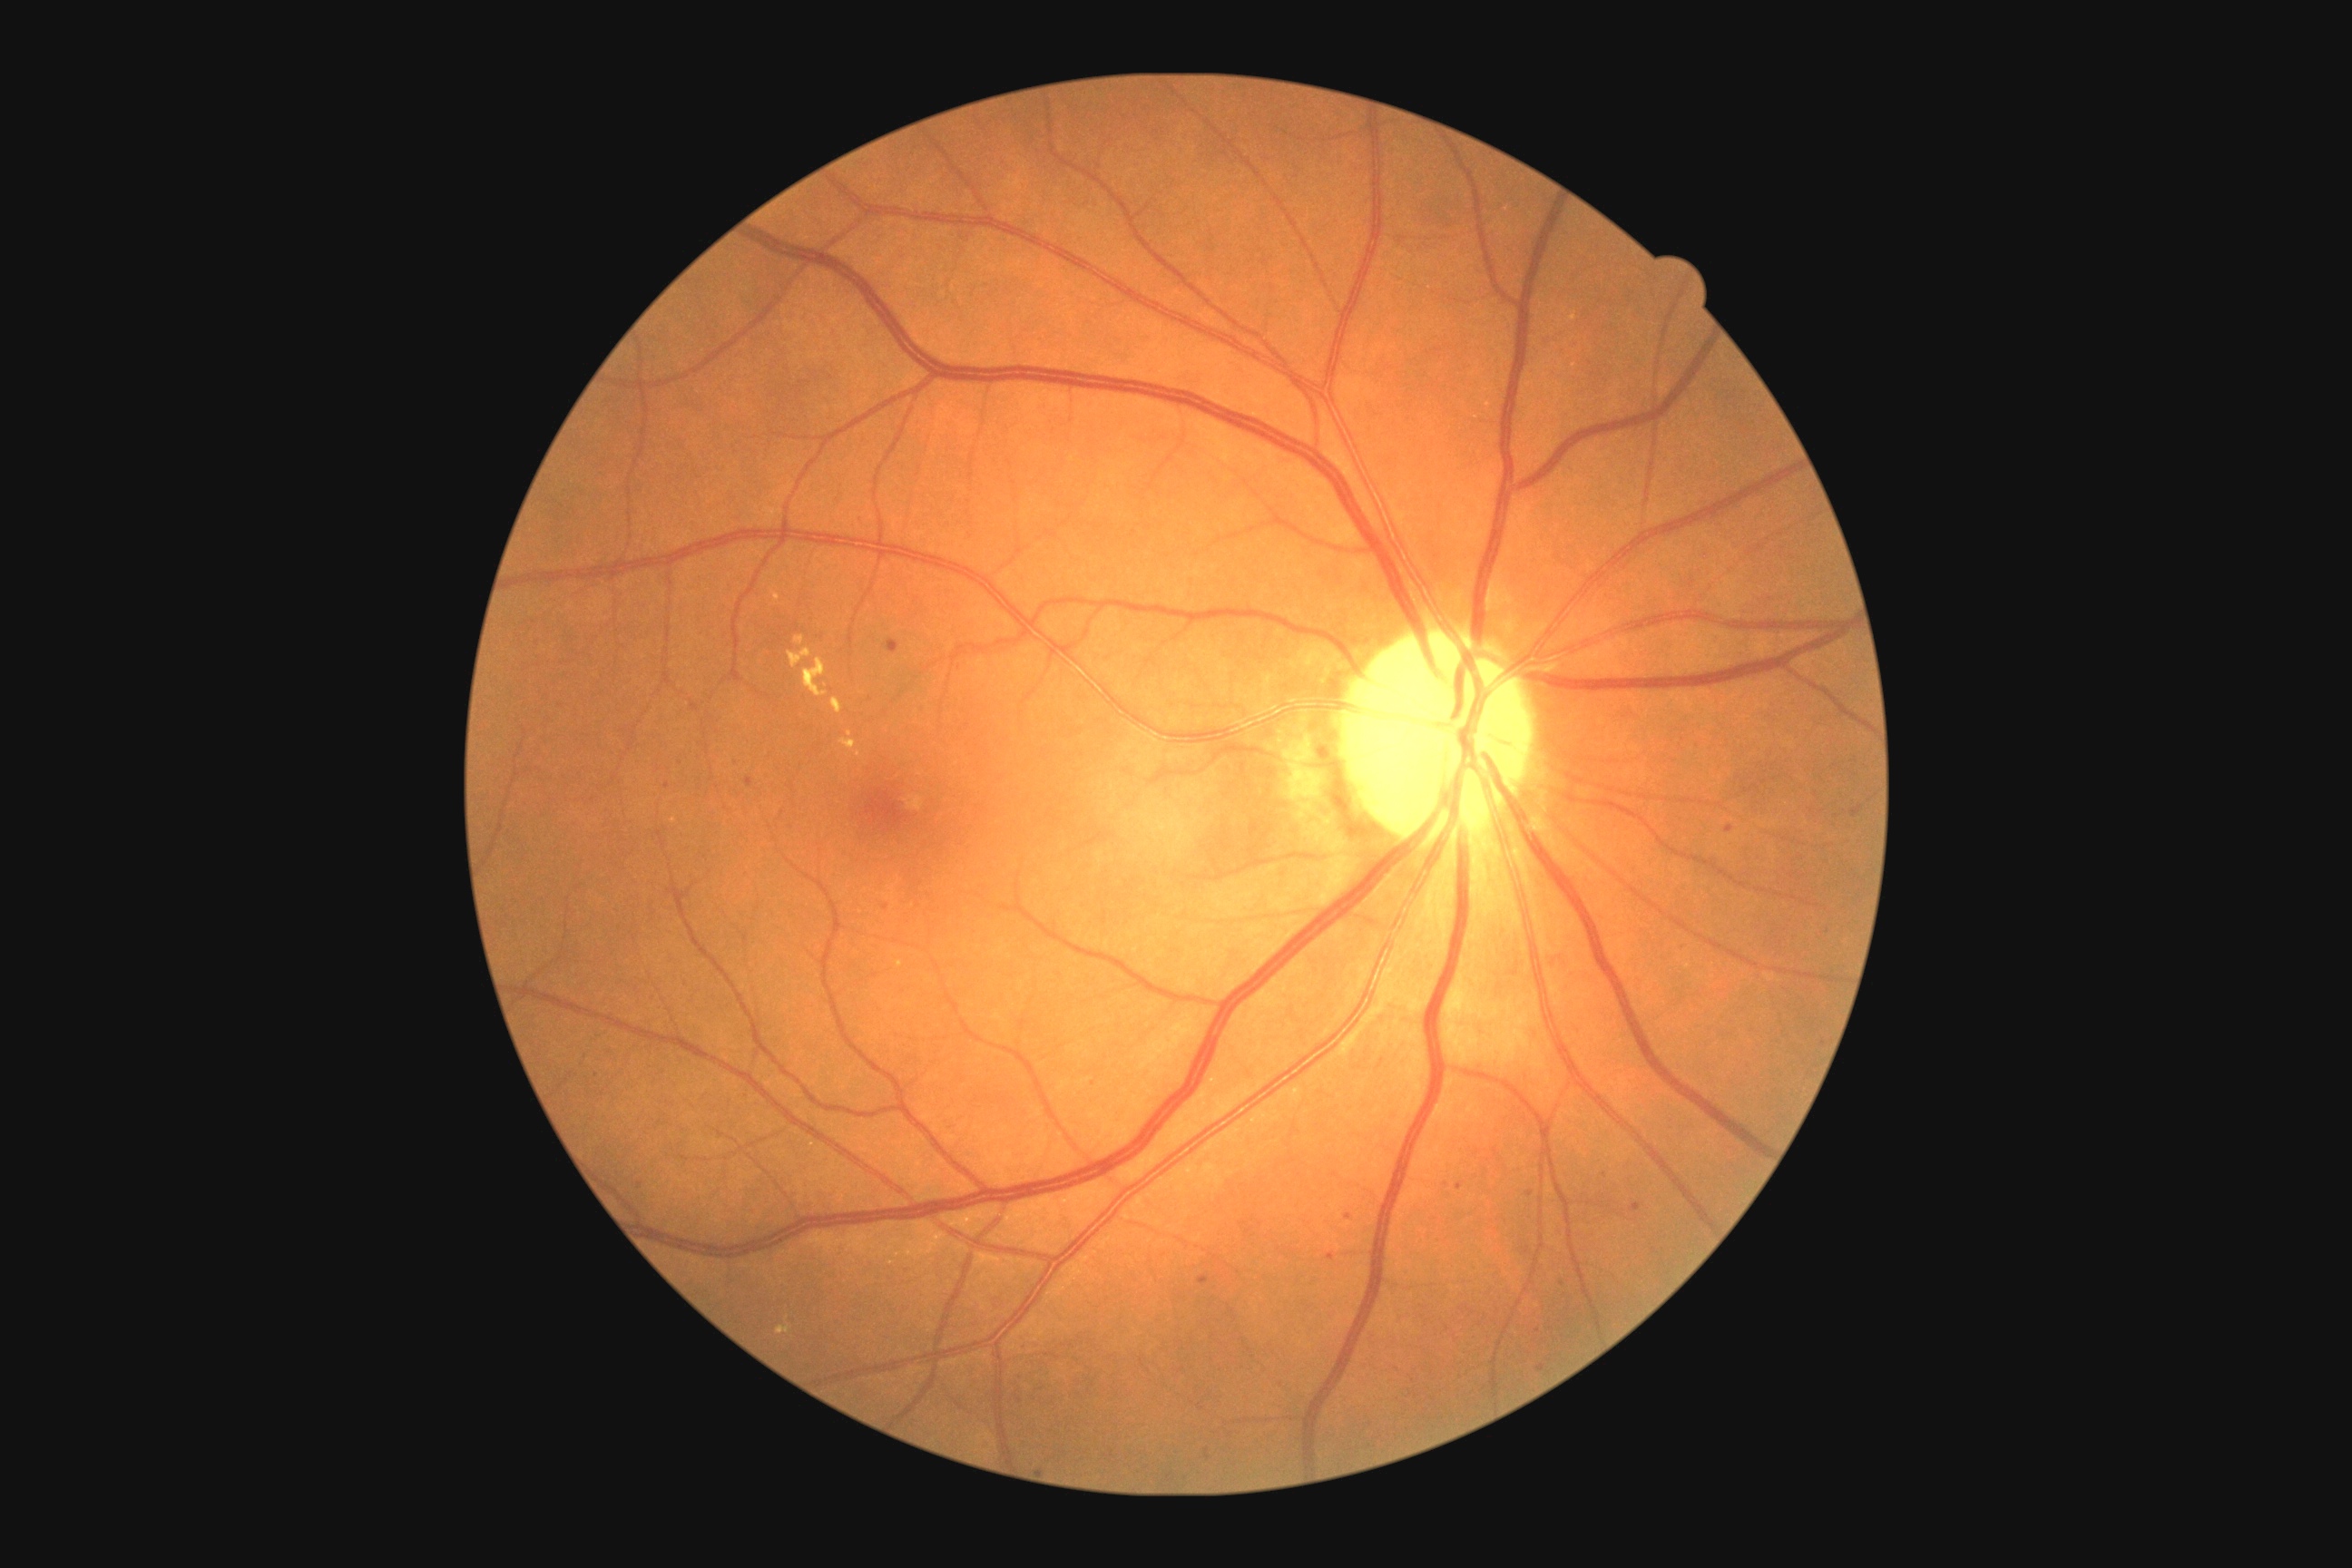 <lesions partial="true">
  <dr_grade>2</dr_grade>
  <ma partial="true">(x1=745, y1=778, x2=754, y2=789), (x1=732, y1=758, x2=740, y2=765), (x1=888, y1=640, x2=899, y2=654), (x1=1538, y1=1364, x2=1545, y2=1373), (x1=1725, y1=825, x2=1734, y2=834)</ma>
  <ma_small_centers>[1335, 1175], [1478, 1152], [1461, 1187], [668, 786], [1348, 1216], [1590, 1204], [1681, 947]</ma_small_centers>
  <se />
  <he>(x1=1317, y1=743, x2=1331, y2=763)</he>
  <ex partial="true">(x1=805, y1=658, x2=828, y2=698), (x1=832, y1=700, x2=843, y2=714), (x1=772, y1=591, x2=779, y2=602), (x1=839, y1=740, x2=858, y2=750), (x1=776, y1=1324, x2=792, y2=1335), (x1=789, y1=649, x2=812, y2=669), (x1=794, y1=636, x2=805, y2=645)</ex>
  <ex_small_centers>[849, 735], [859, 754], [788, 1318]</ex_small_centers>
</lesions>